Captured with the Natus RetCam Envision (130° field of view) · infant wide-field fundus photograph.
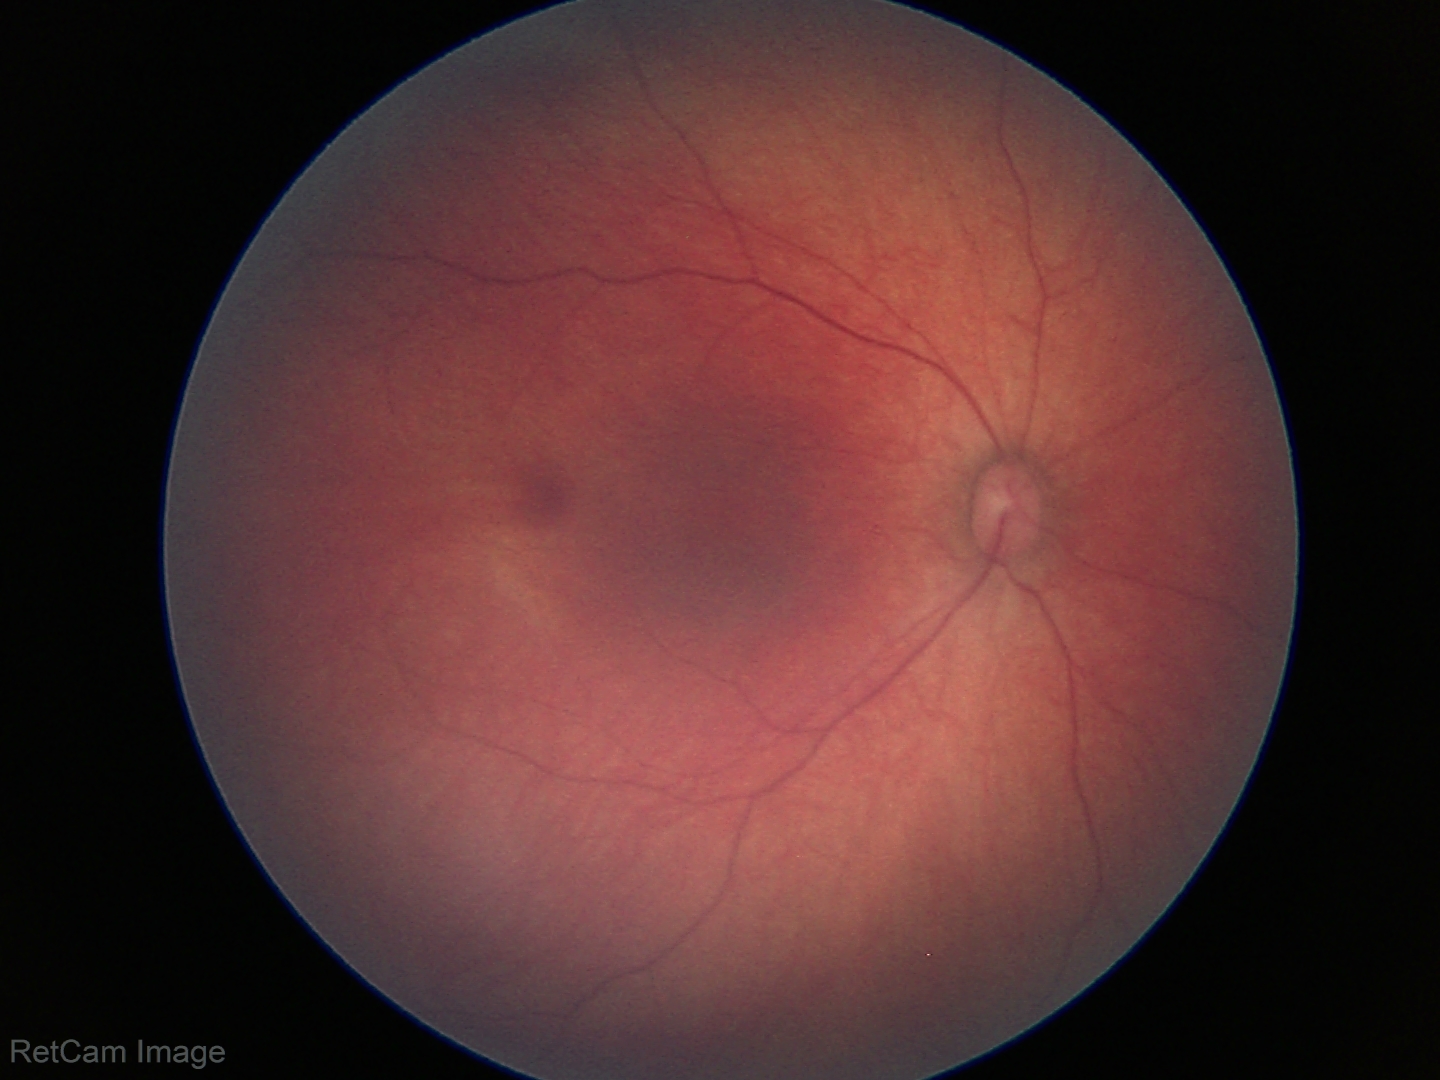

Examination with physiological retinal findings.